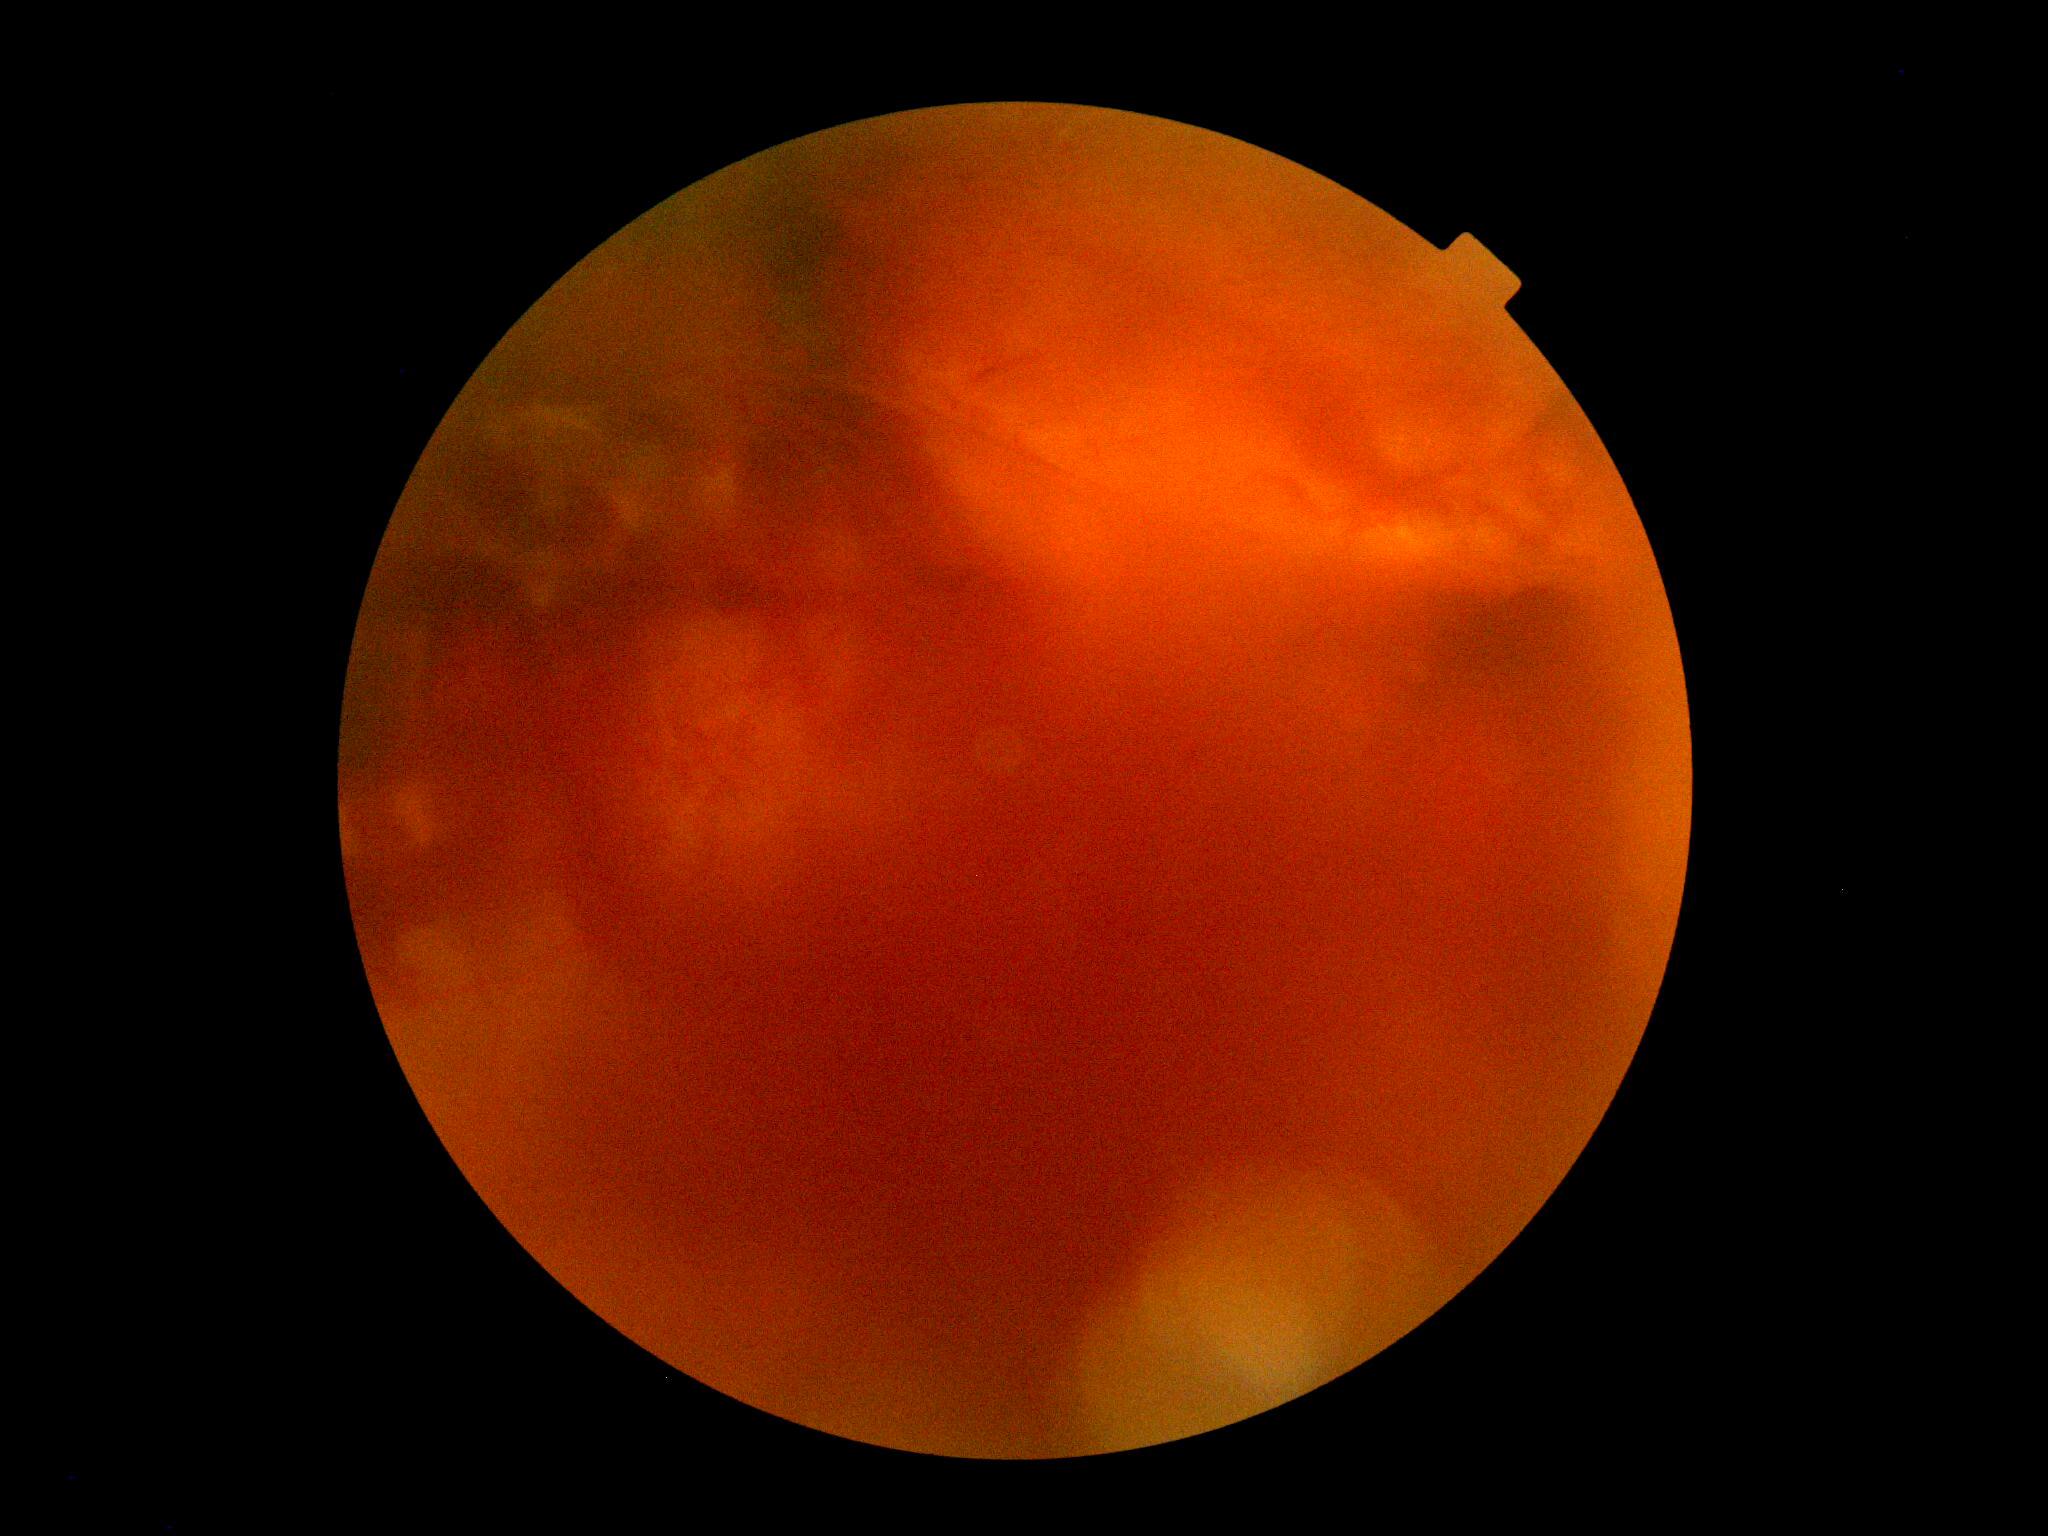 DR grade: 4.